Image size 640x480 · pediatric retinal photograph (wide-field):
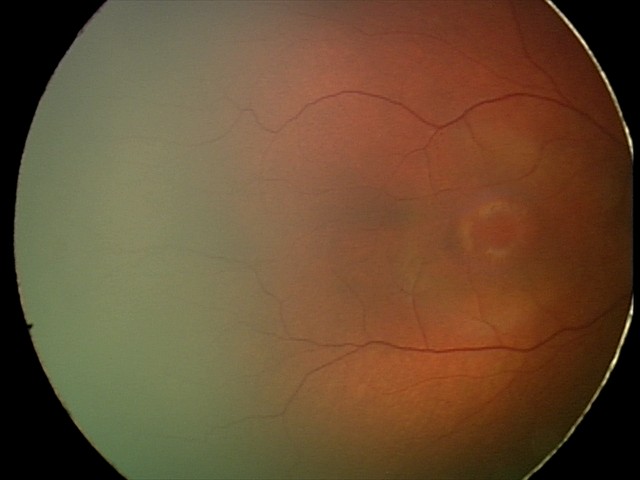
Q: What is the diagnosis from this examination?
A: physiological appearance with no retinal pathology